45° FOV; 1380 x 1382 pixels:
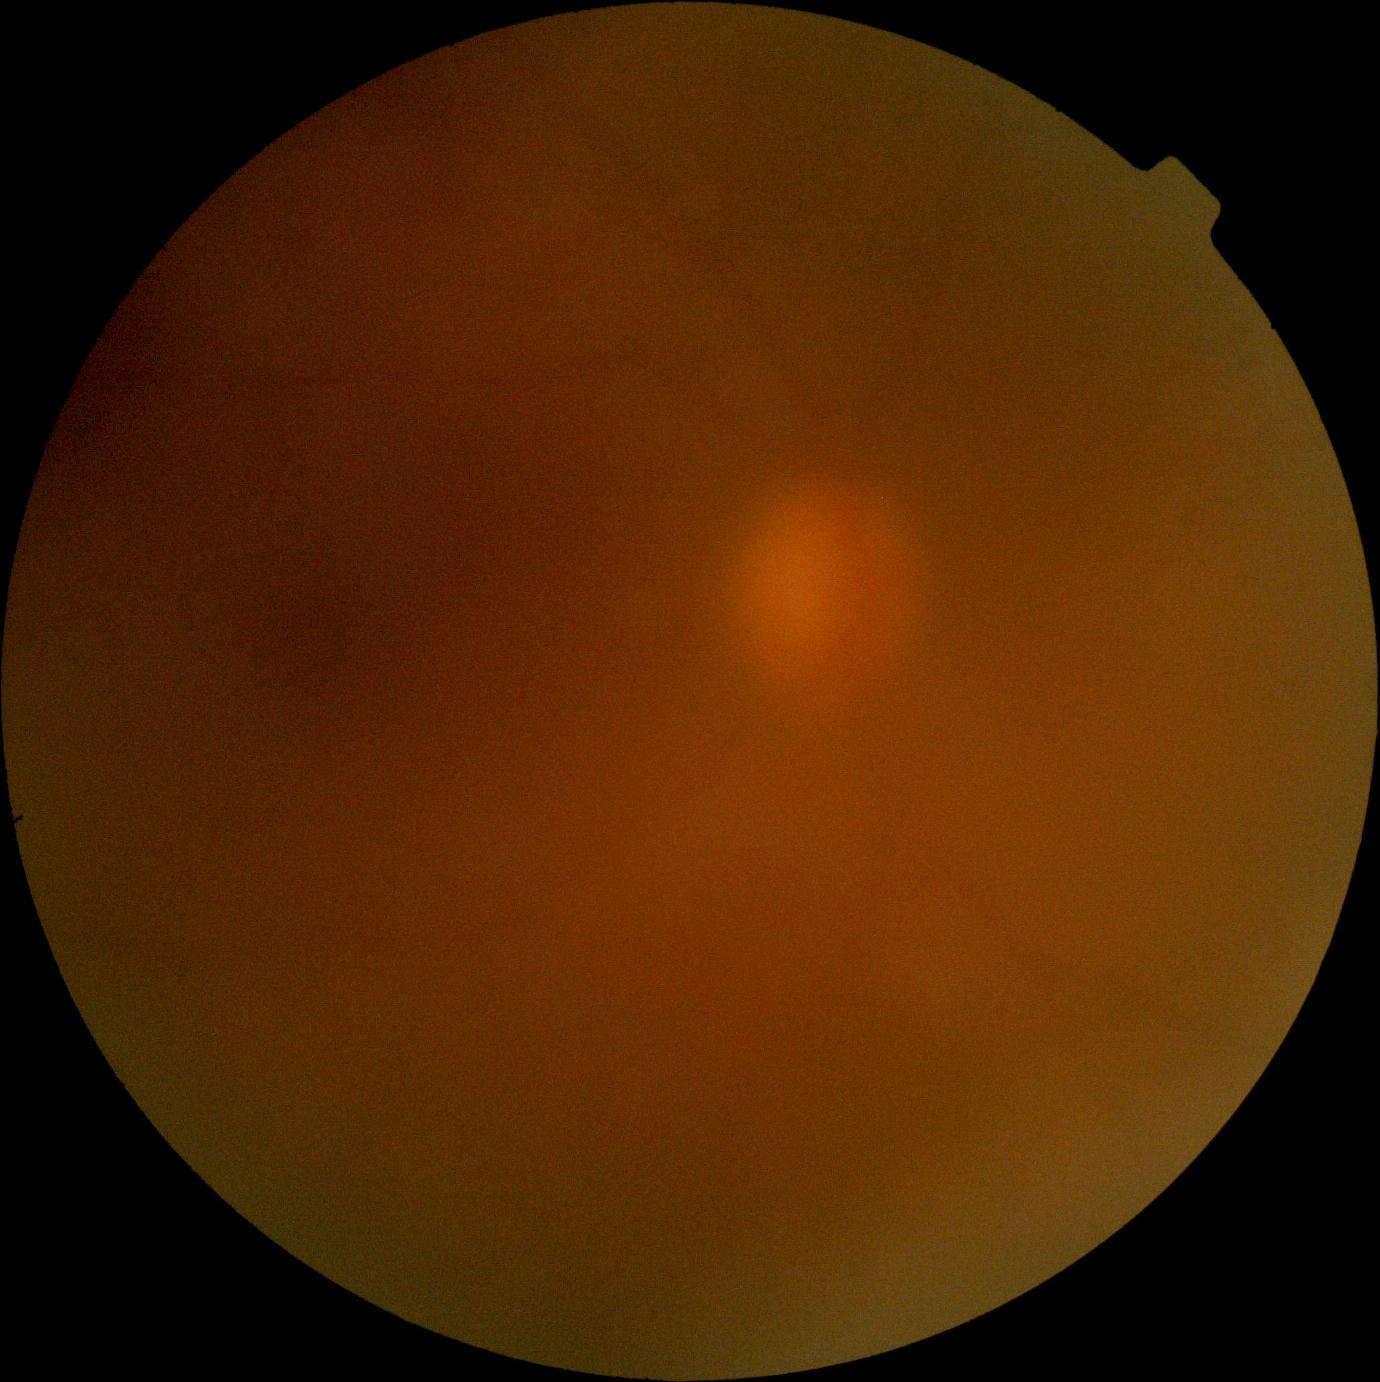 DR severity is ungradable due to poor image quality.